Color fundus photograph.
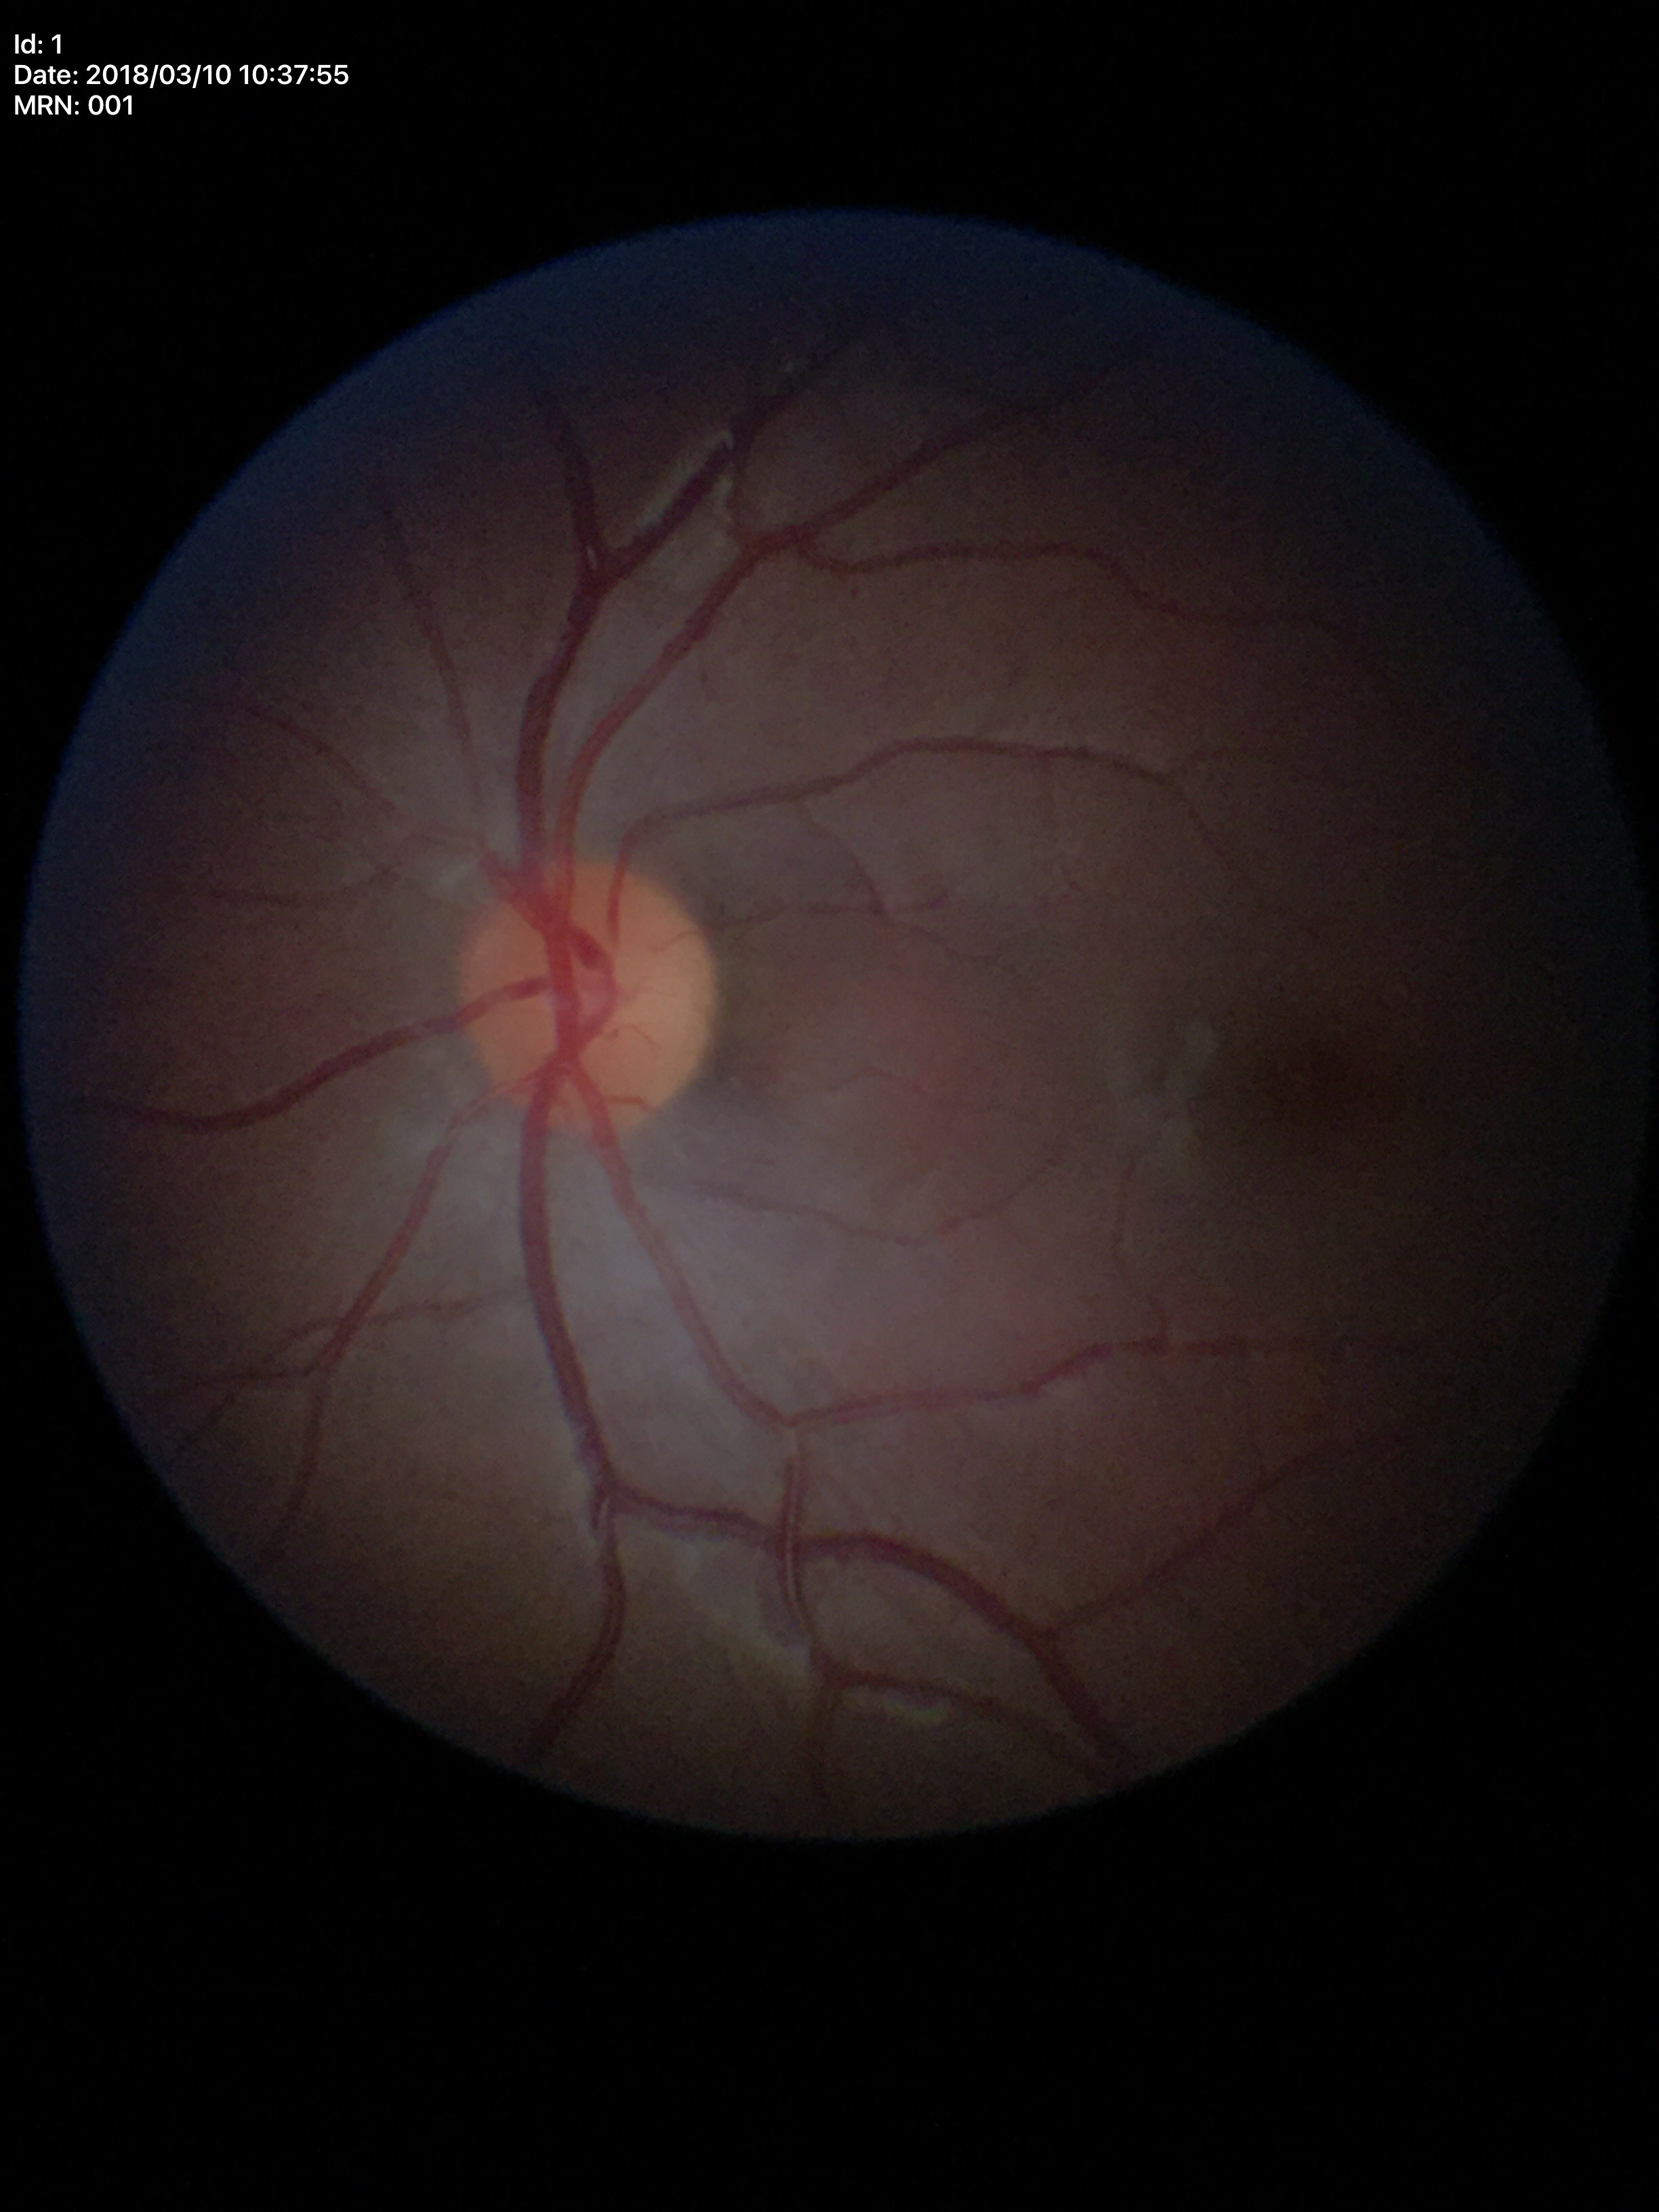
Glaucoma screening: no suspicious findings.
ACDR: 0.18.
VCDR of 0.41.
HCDR is 0.44.